Captured with the Phoenix ICON (100° field of view); pediatric wide-field fundus photograph:
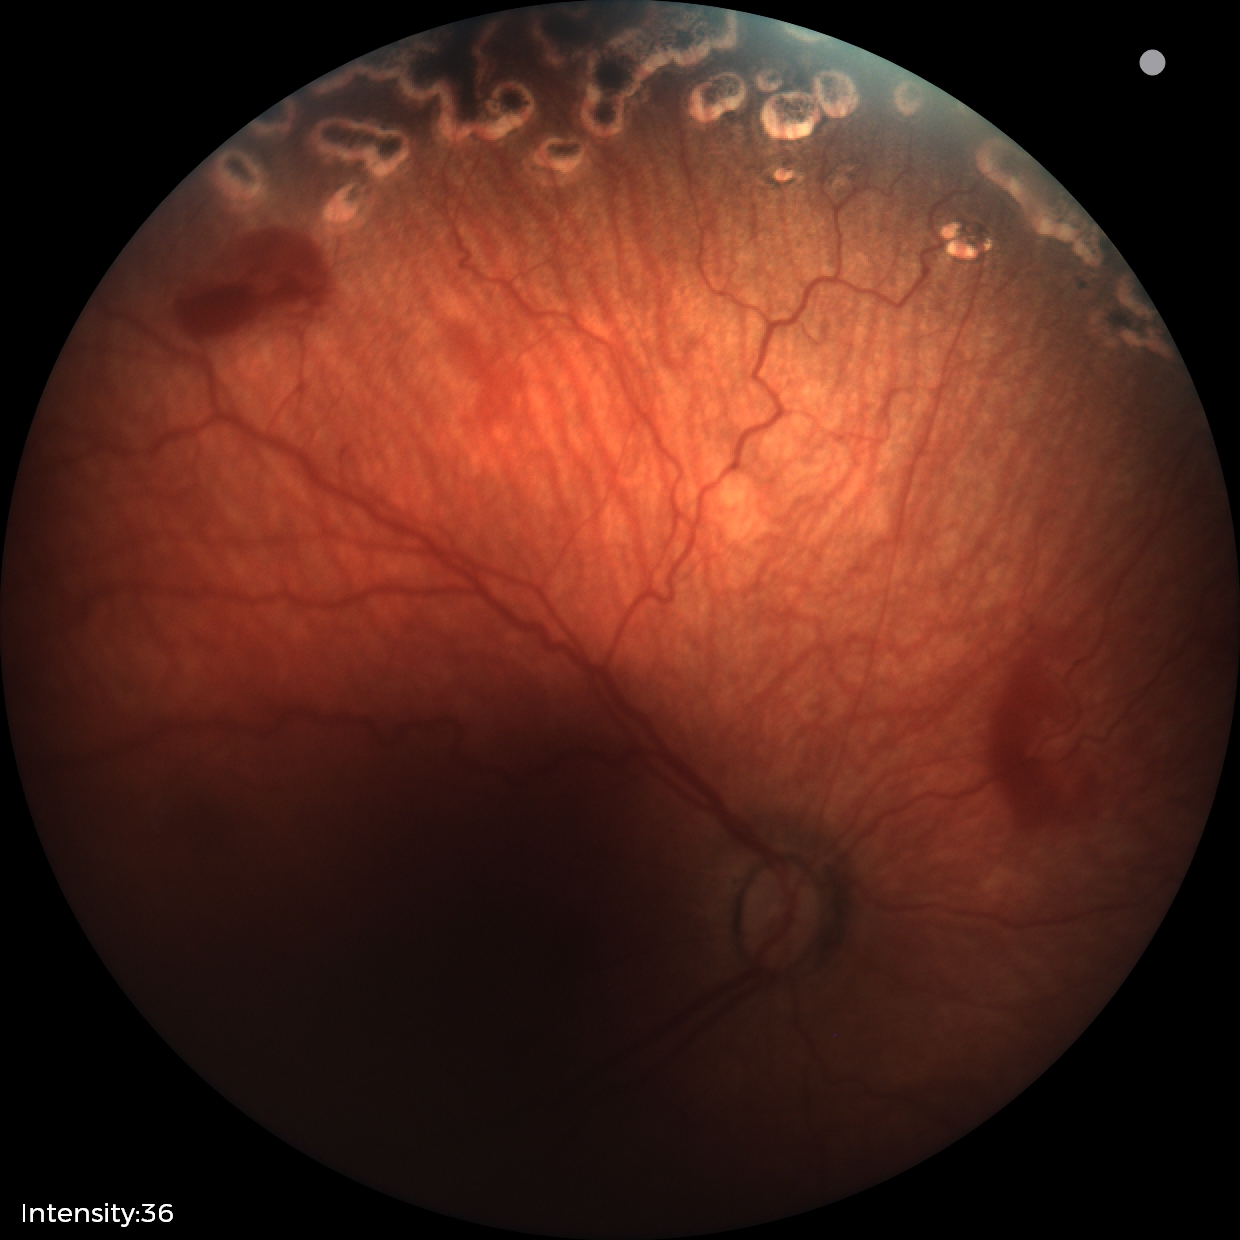

Plus disease: absent, impression: status post retinopathy of prematurity.